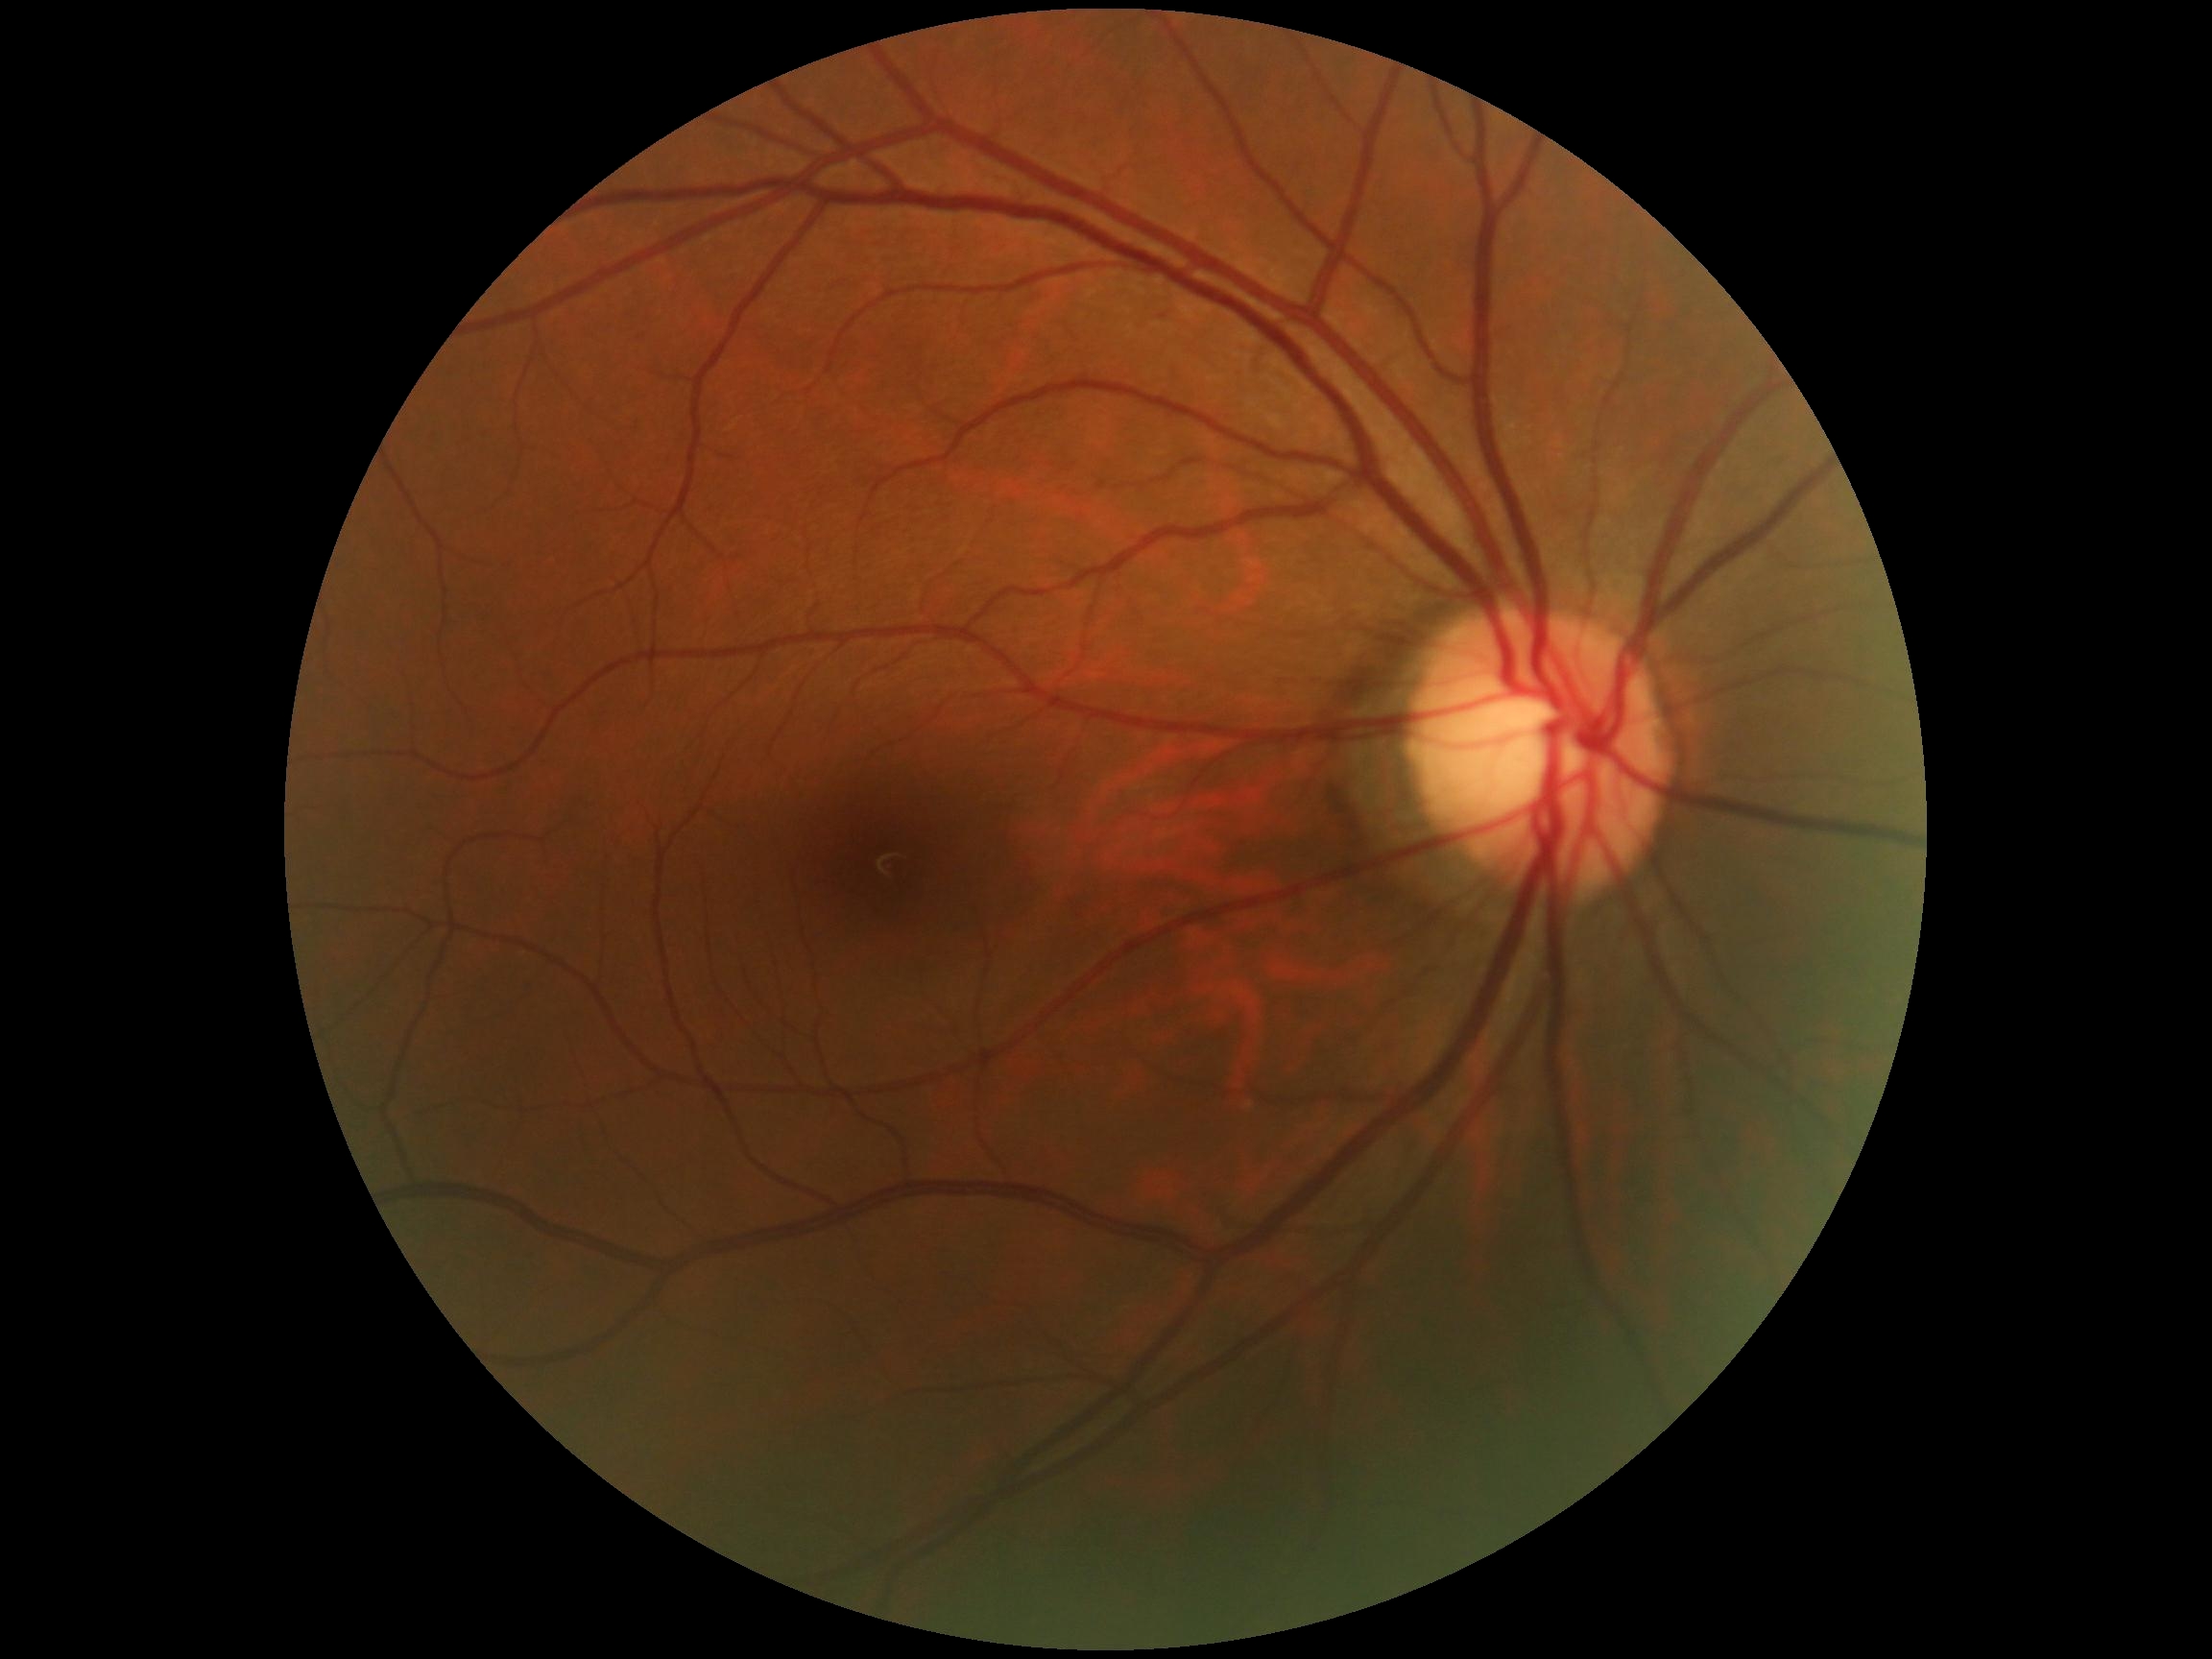

Diabetic retinopathy (DR) is no apparent diabetic retinopathy (grade 0). No DR findings.